Image size 640x480. 130° field of view (Clarity RetCam 3). Infant wide-field retinal image:
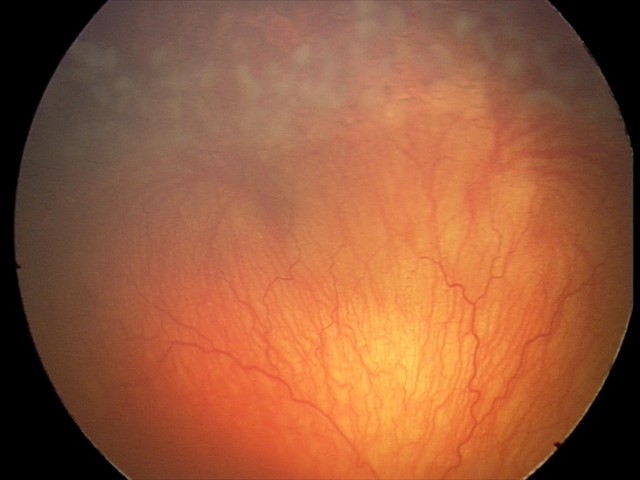 Series diagnosed as aggressive retinopathy of prematurity.